Remidio Fundus on Phone (FOP) camera.
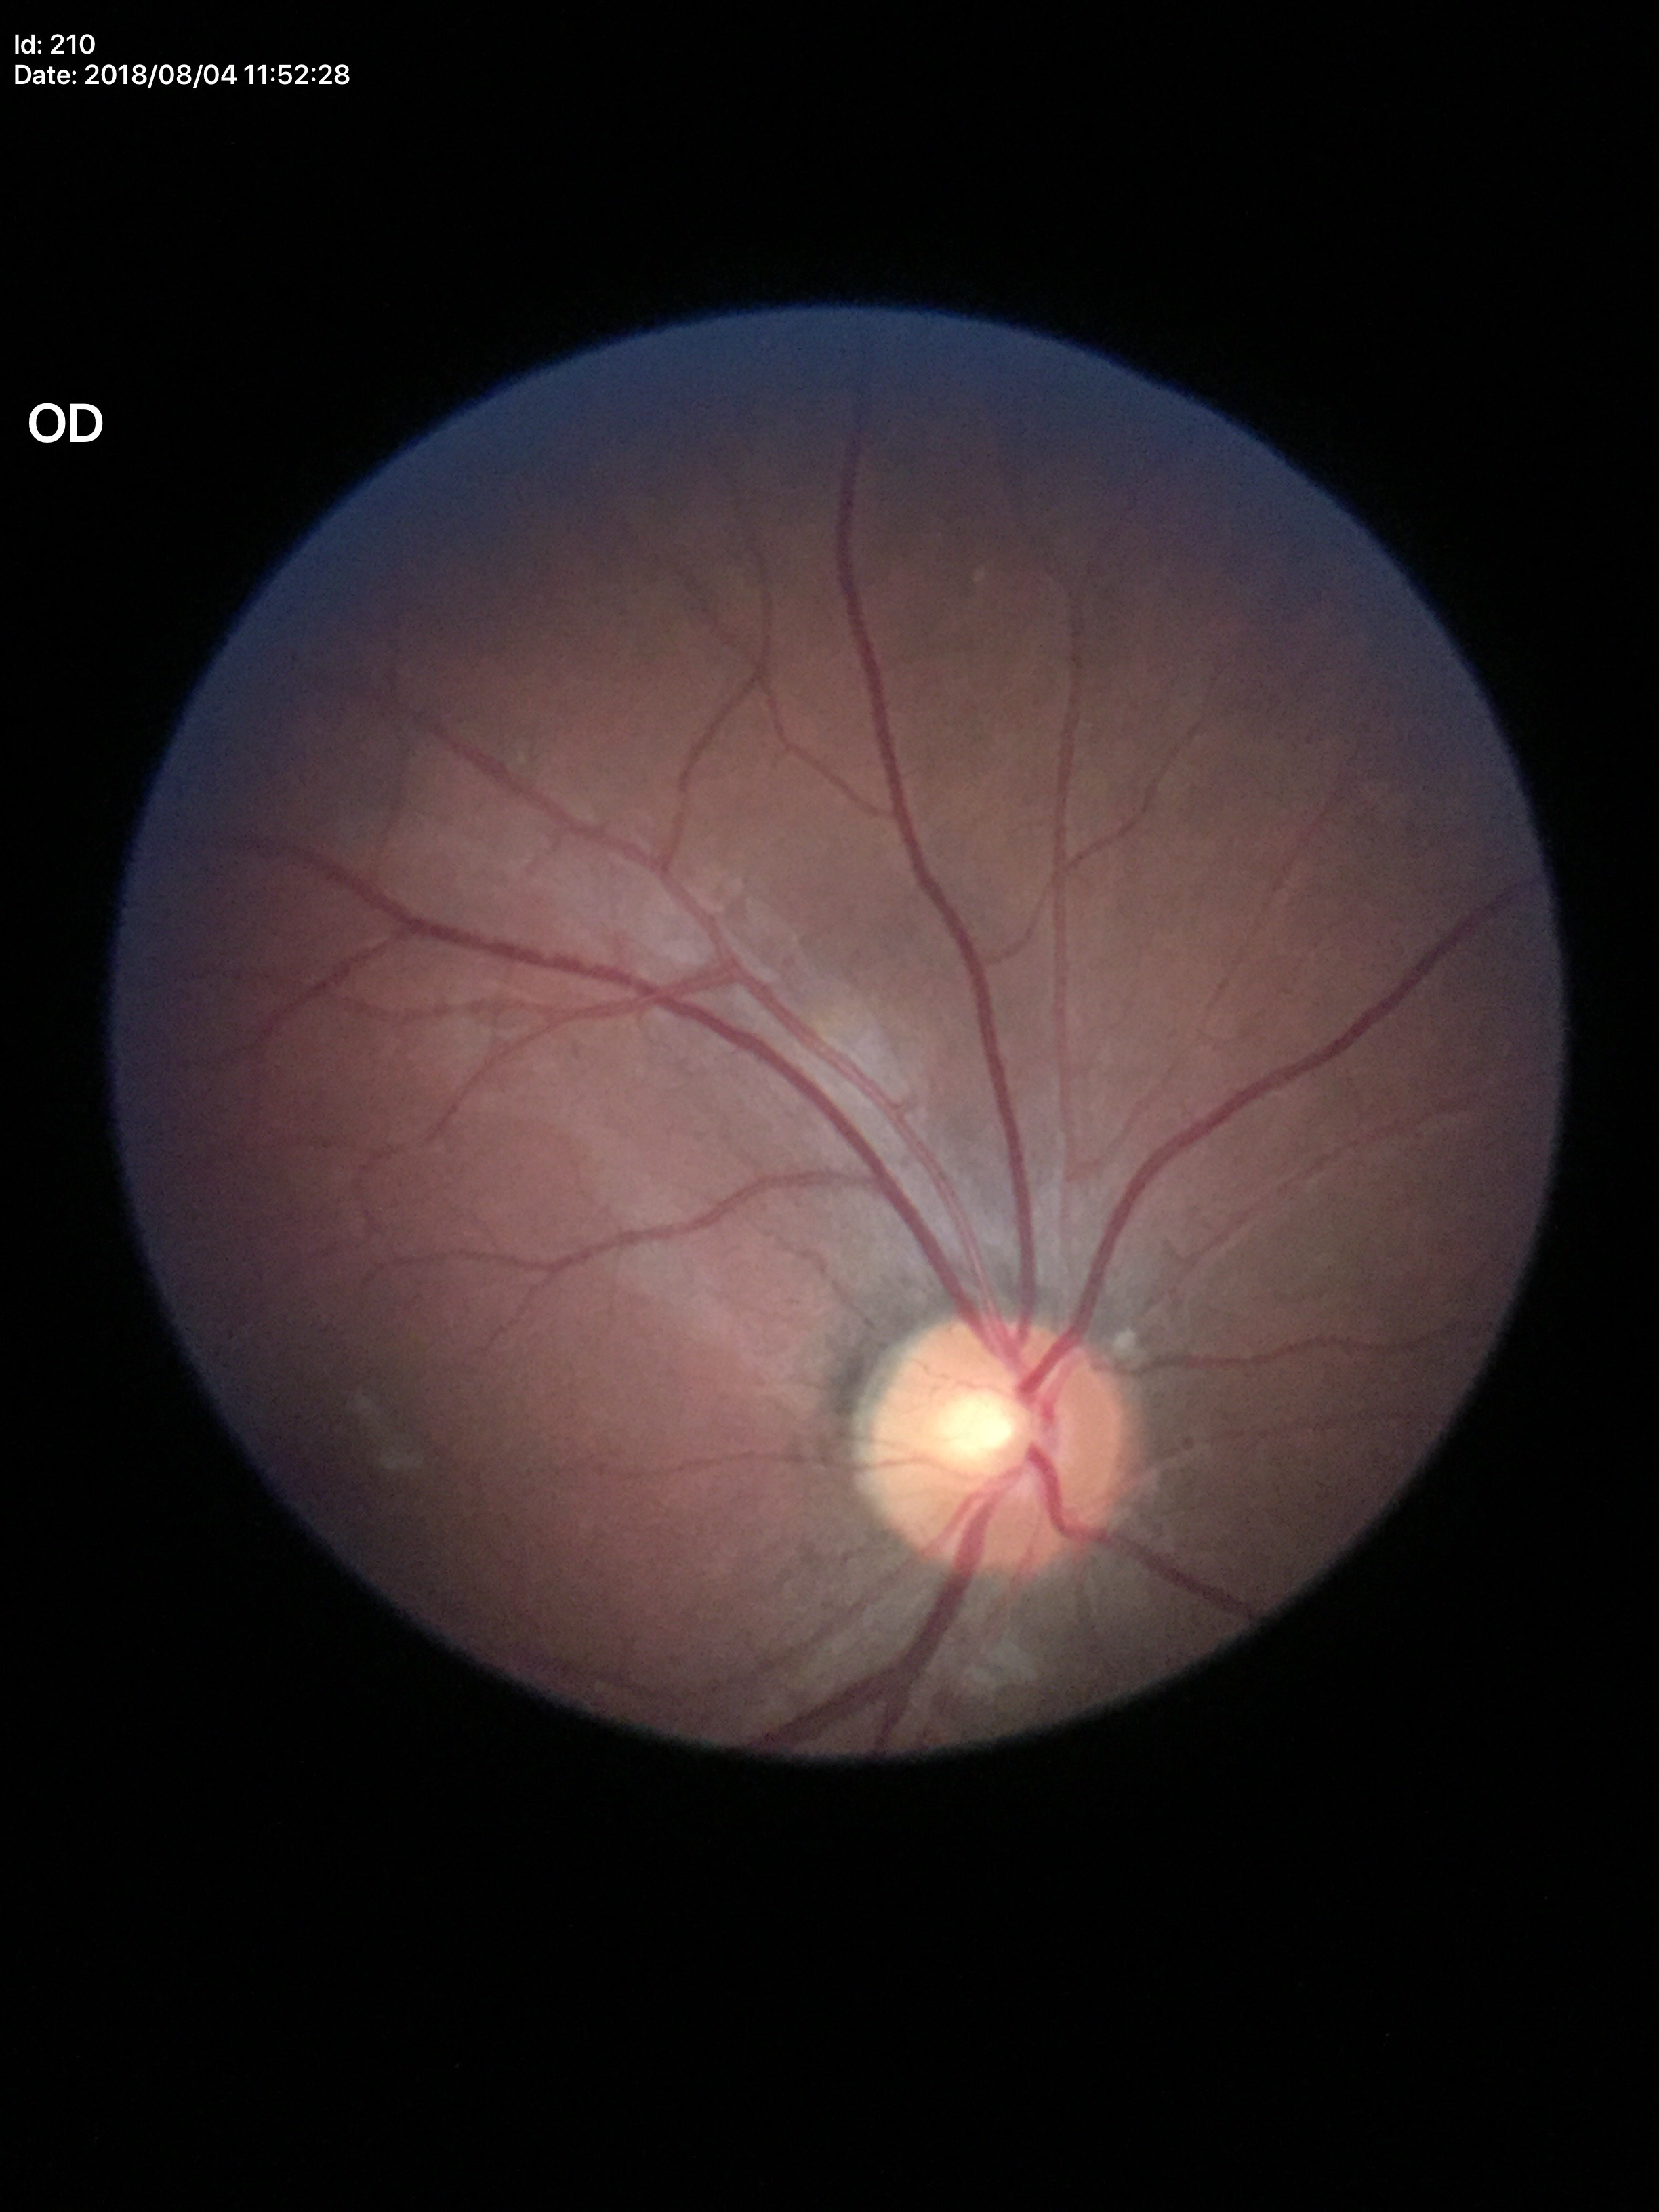 Vertical CDR (VCDR) of 0.49. Horizontal cup-disc ratio (HCDR) of 0.54. Not suspicious for glaucoma.